CFP, mydriatic (tropicamide and phenylephrine), image size 2228x1652 — 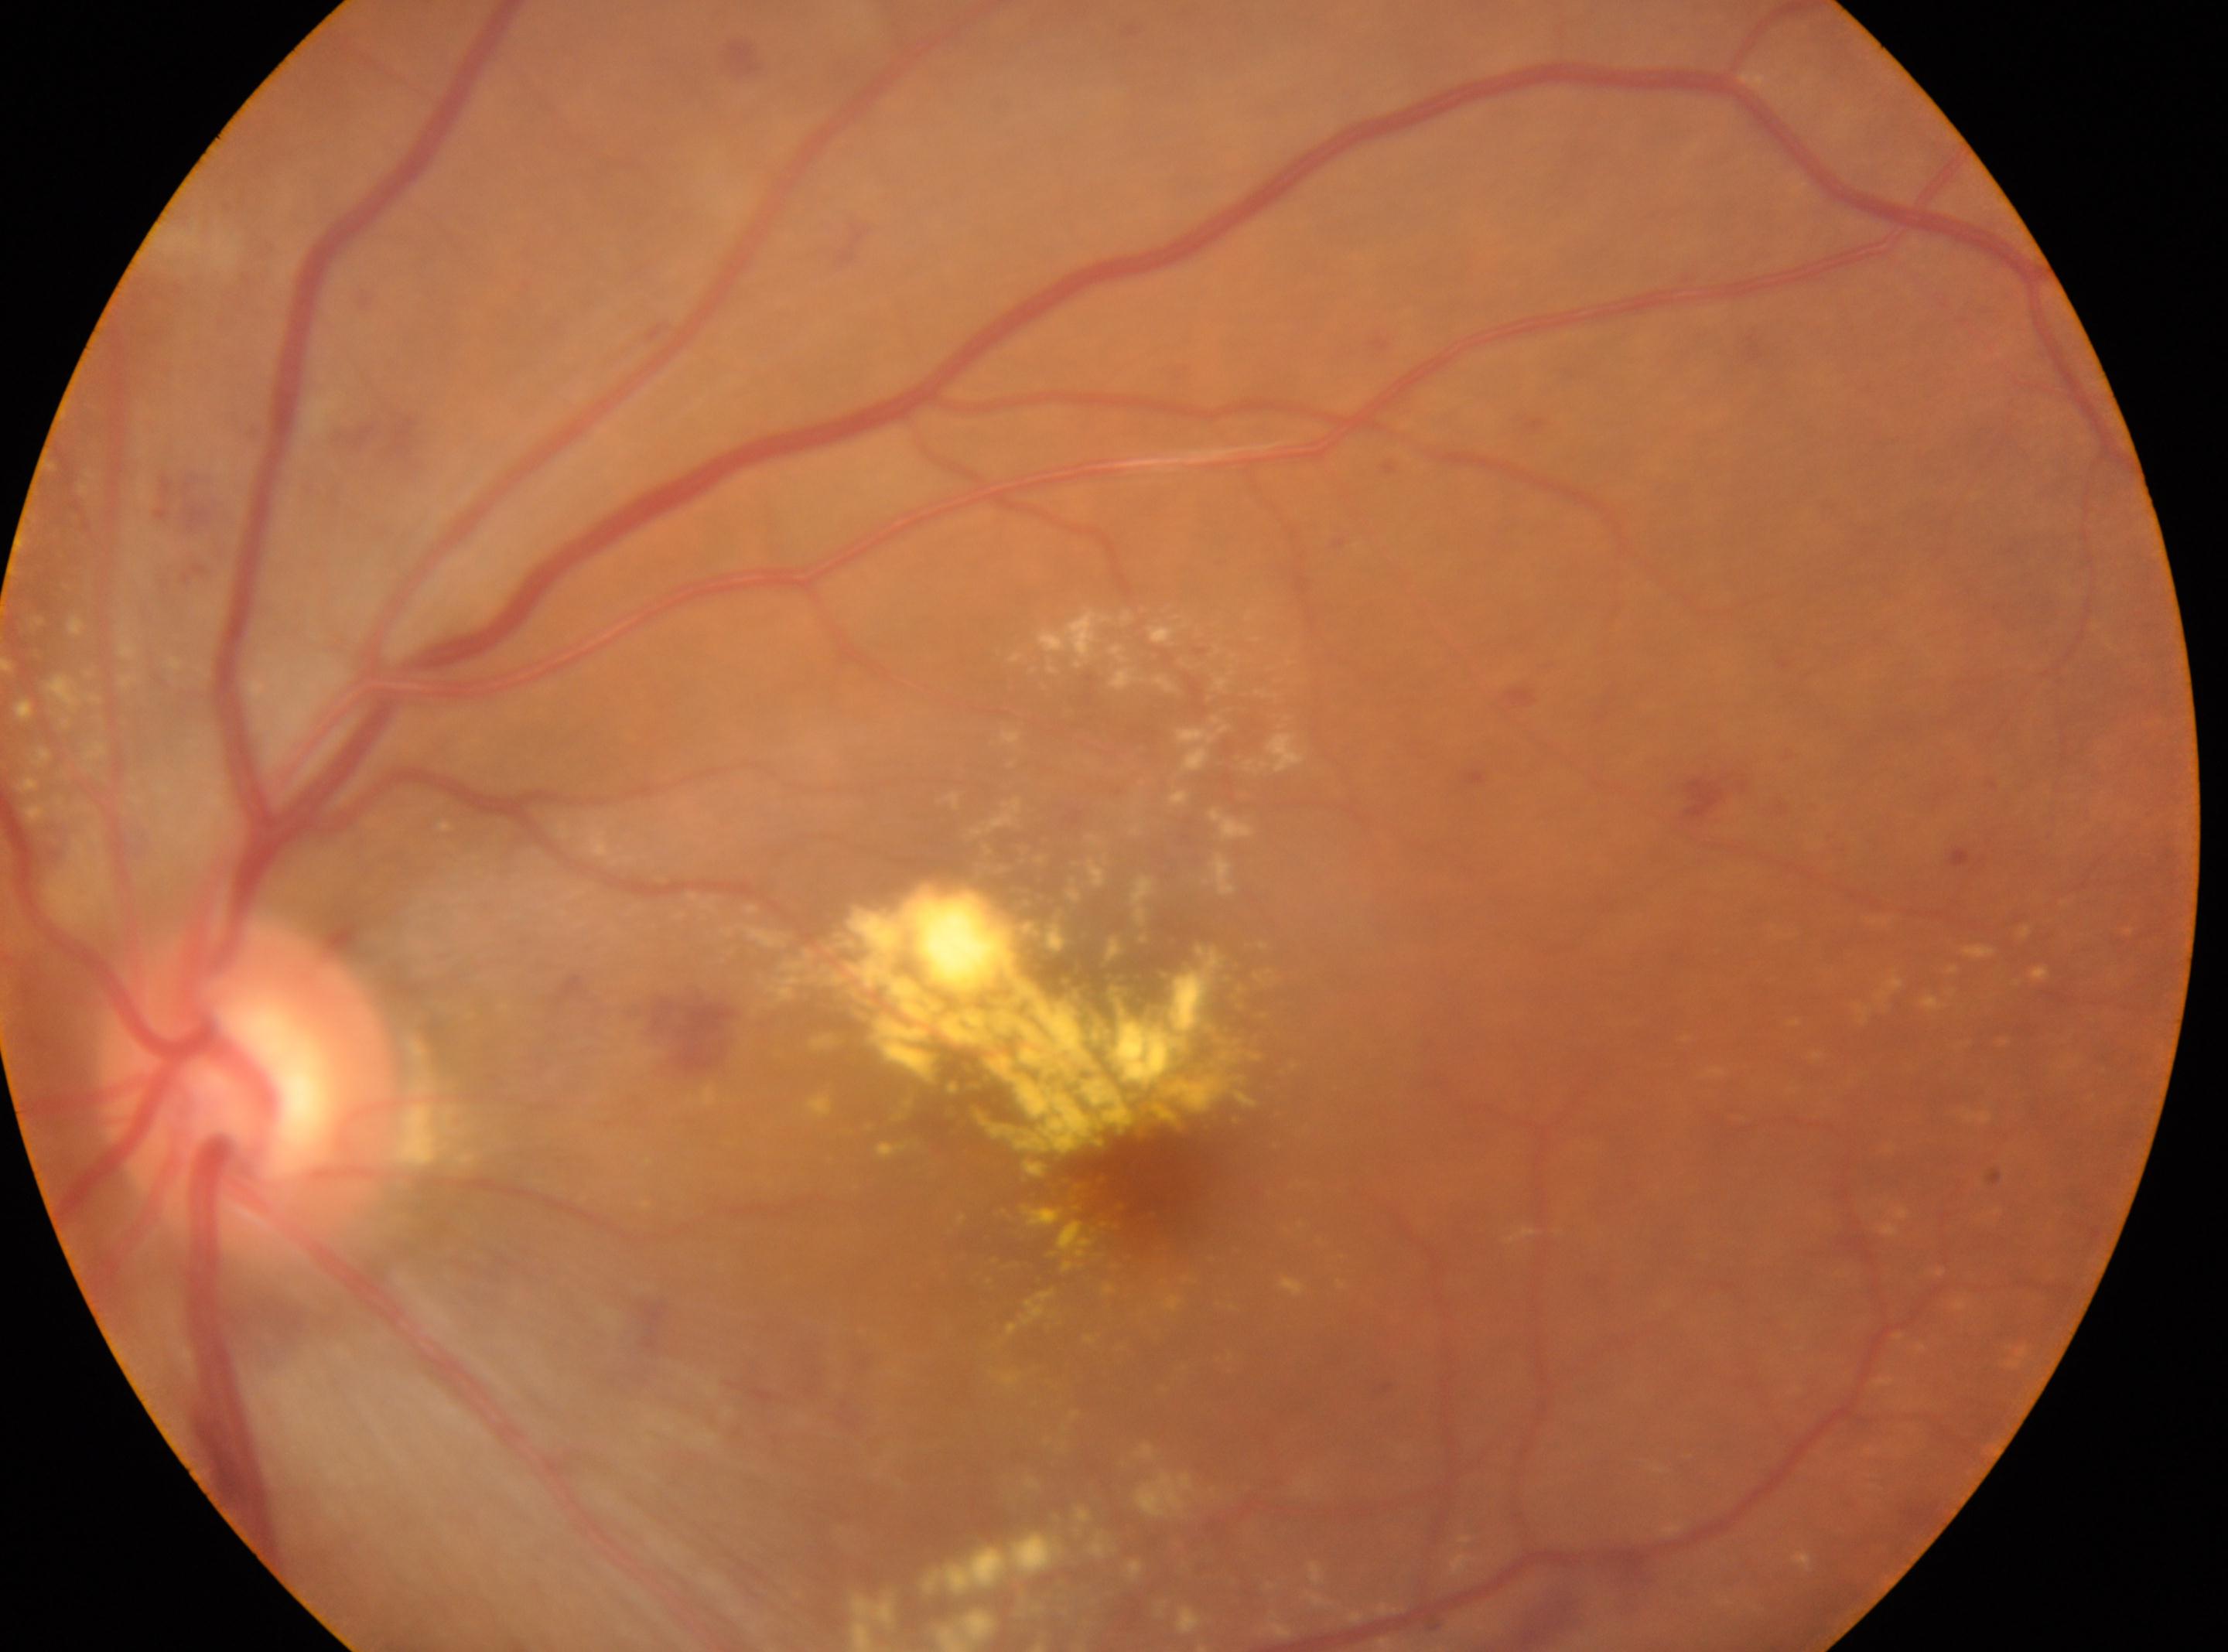 Diabetic retinopathy (DR) is 2.
The macular center is at [1151, 1179].
Eye: left eye.
ONH: [246, 1087].